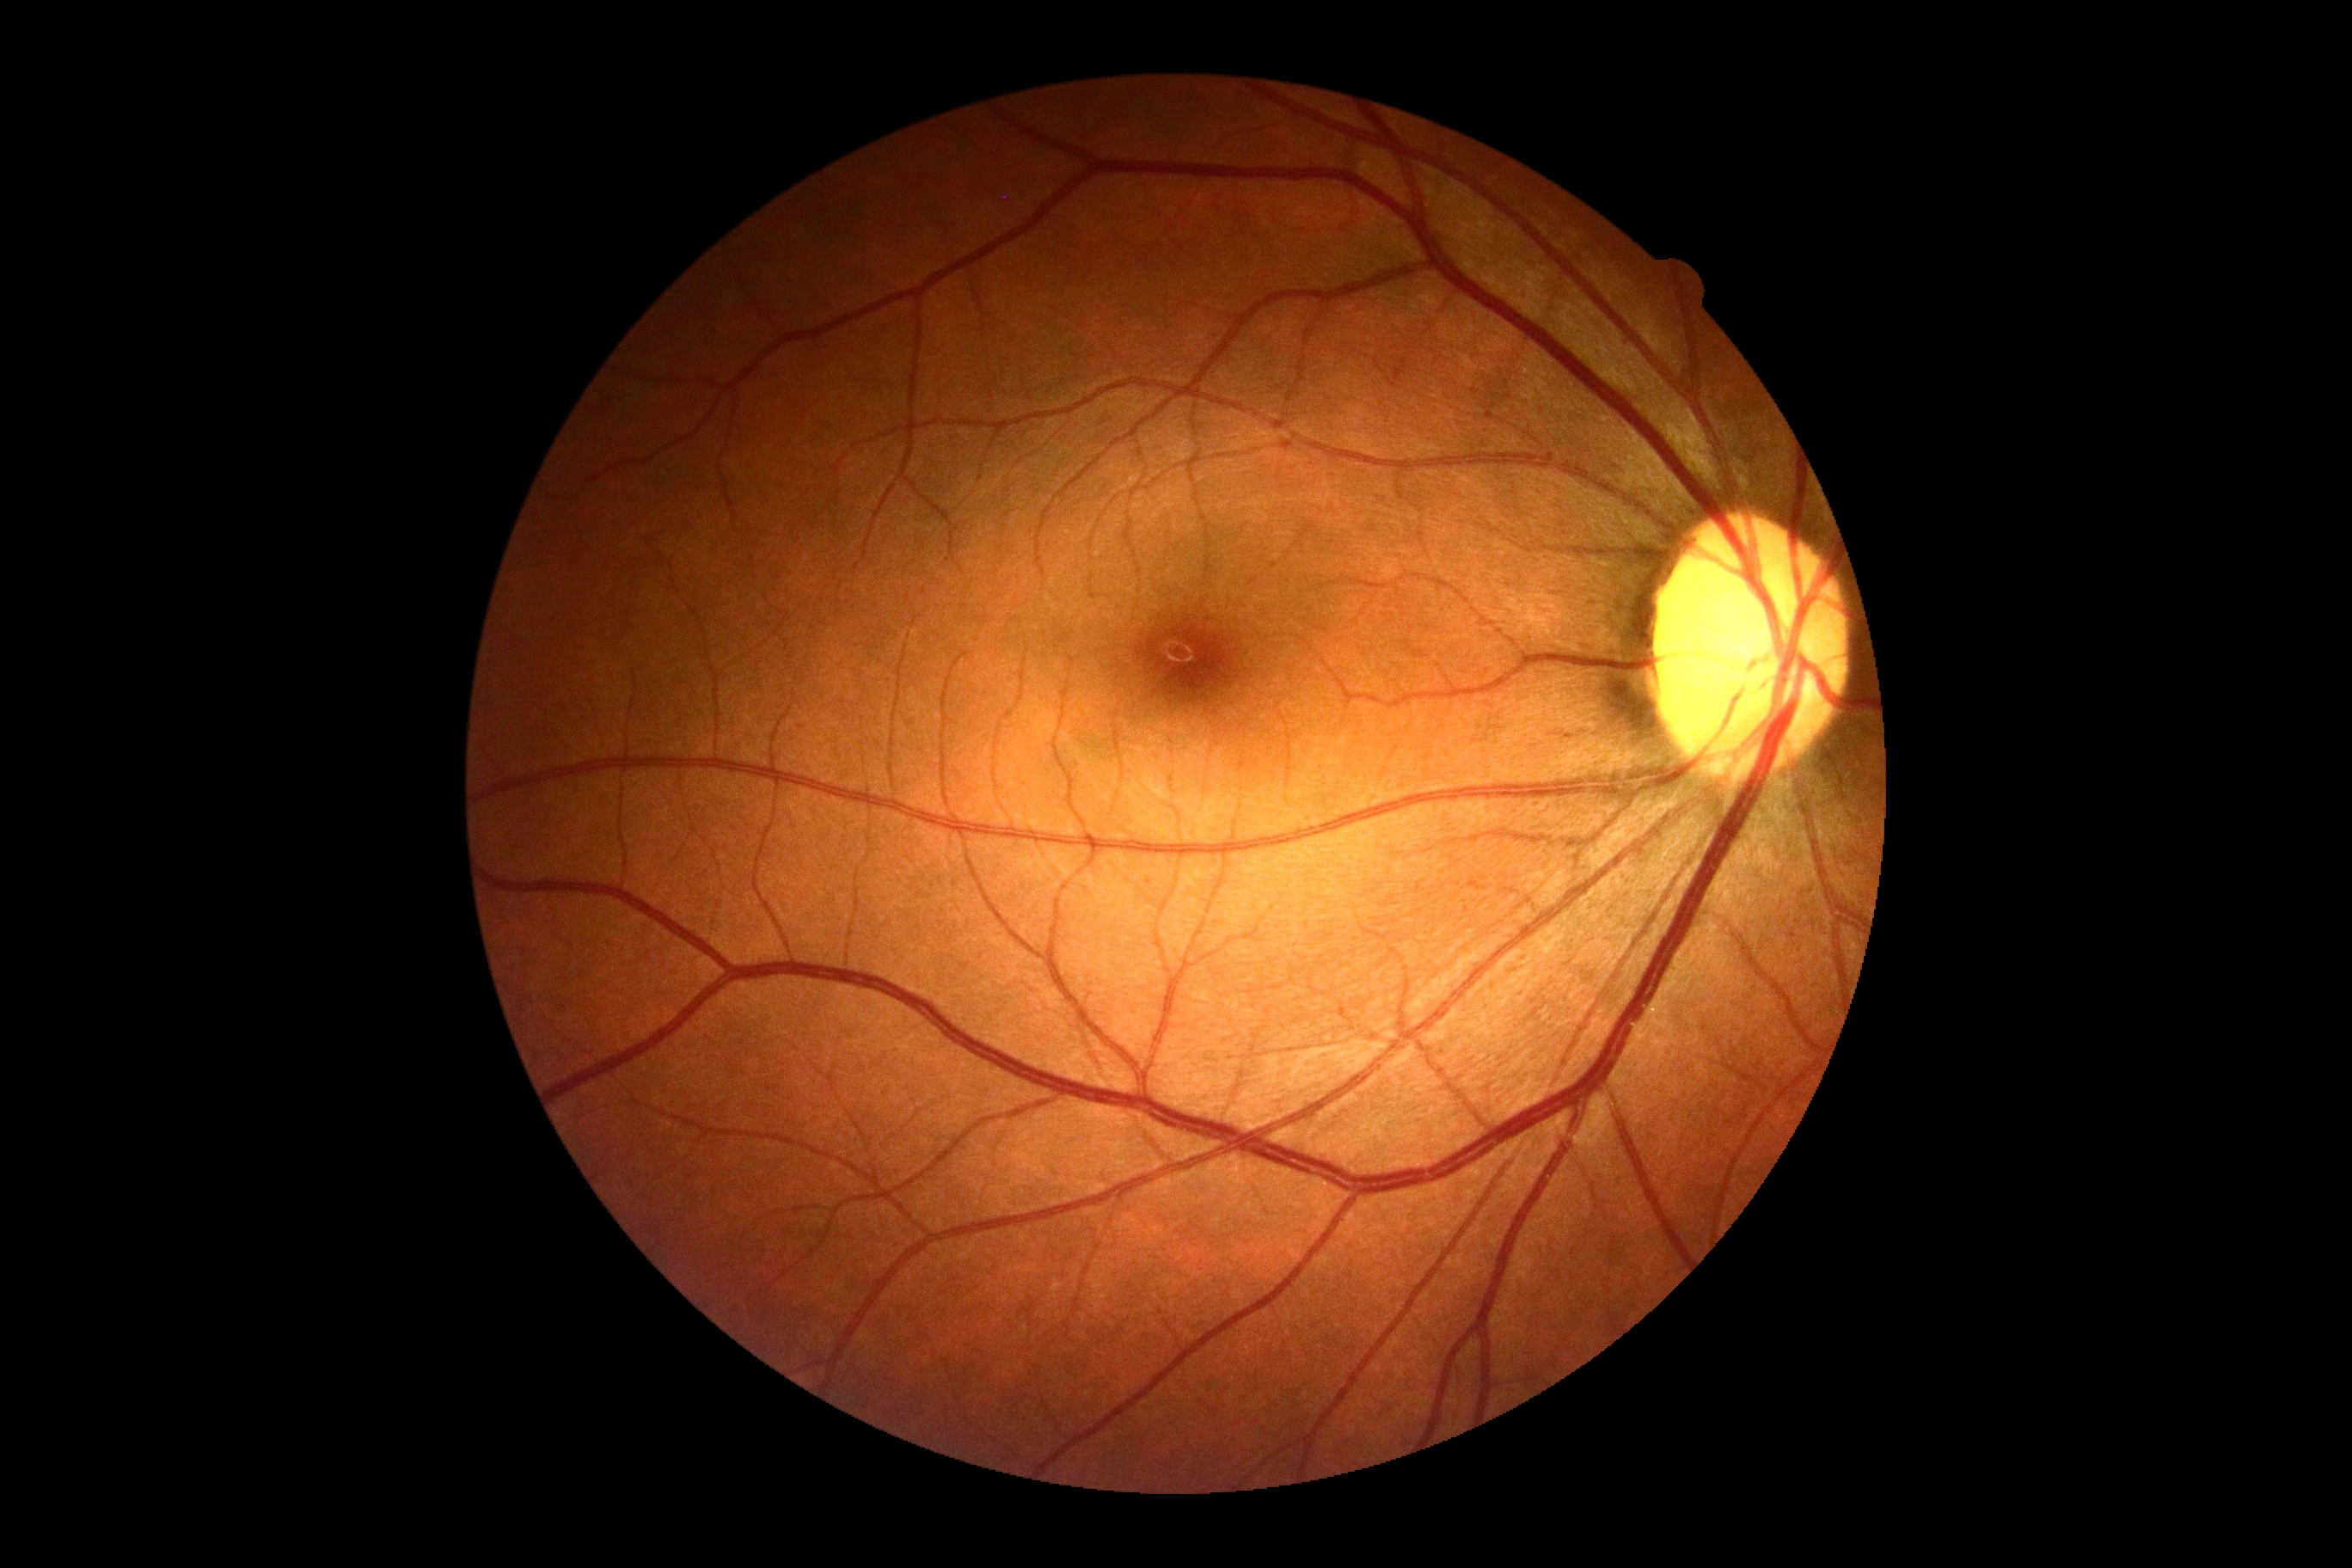
{
  "dr_grade": "no apparent retinopathy (grade 0)"
}